Wide-field fundus image from infant ROP screening. 1240 x 1240 pixels
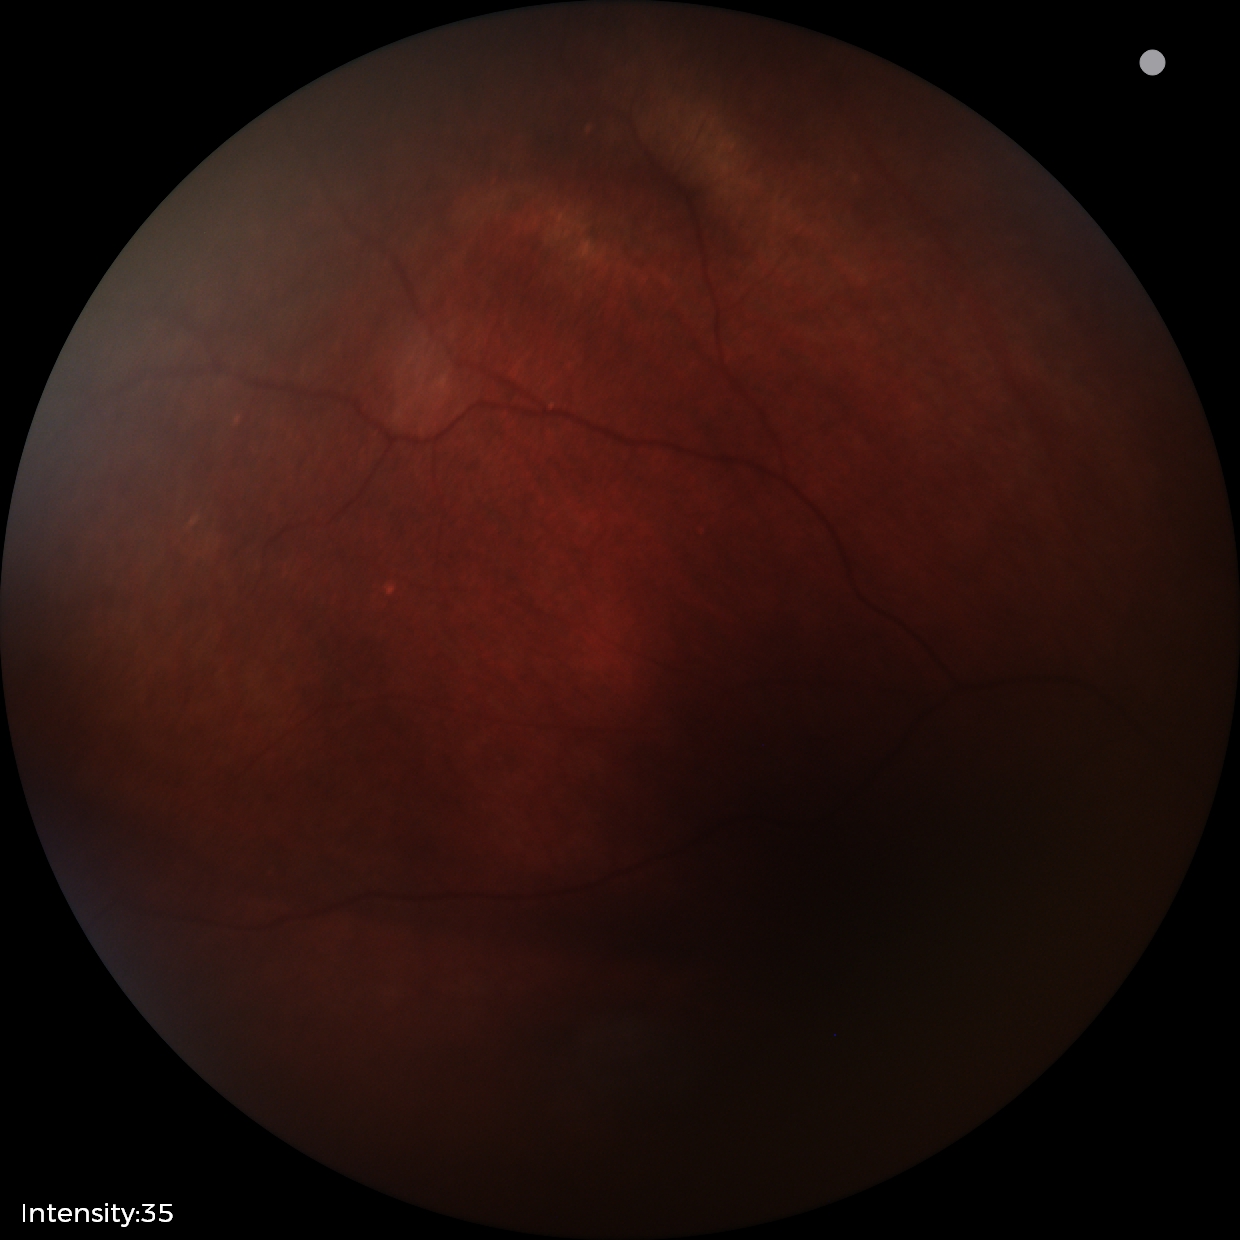 Series diagnosed as retinal astrocytic hamartoma.